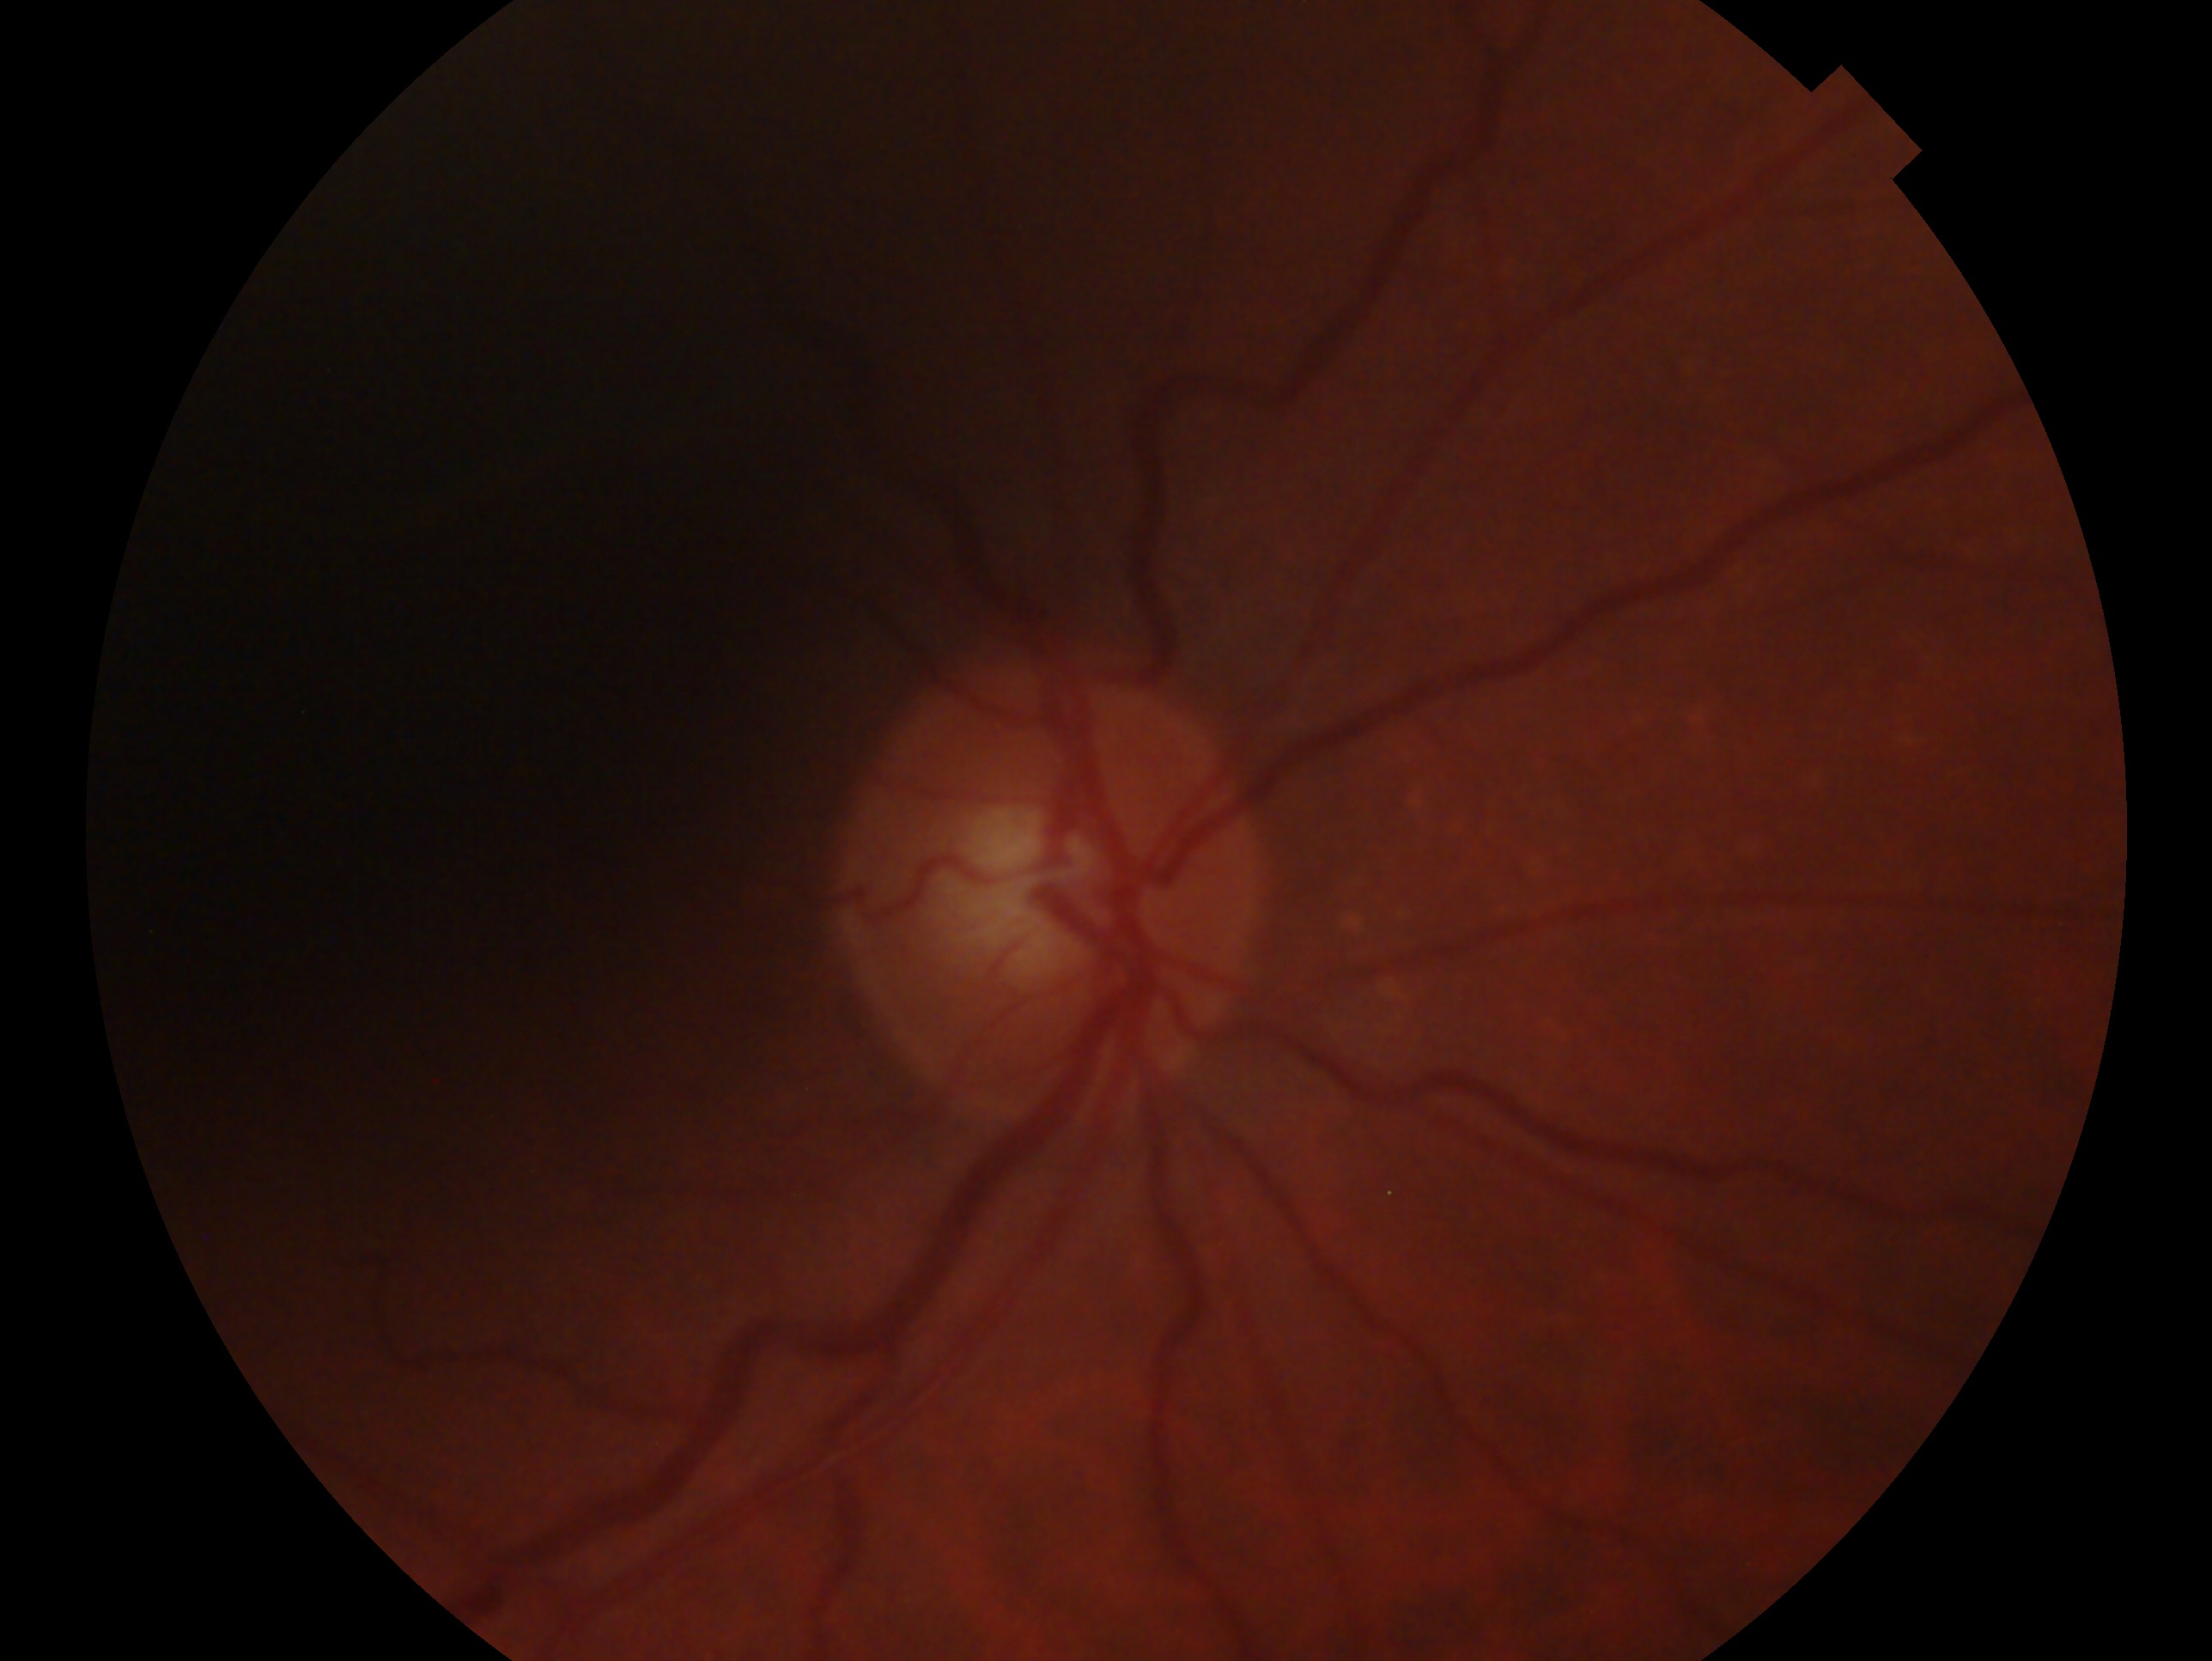

laterality = right eye | impression = no glaucoma — no clinical evidence of glaucoma in this eye.